Retinal fundus photograph. 2352 by 1568 pixels:
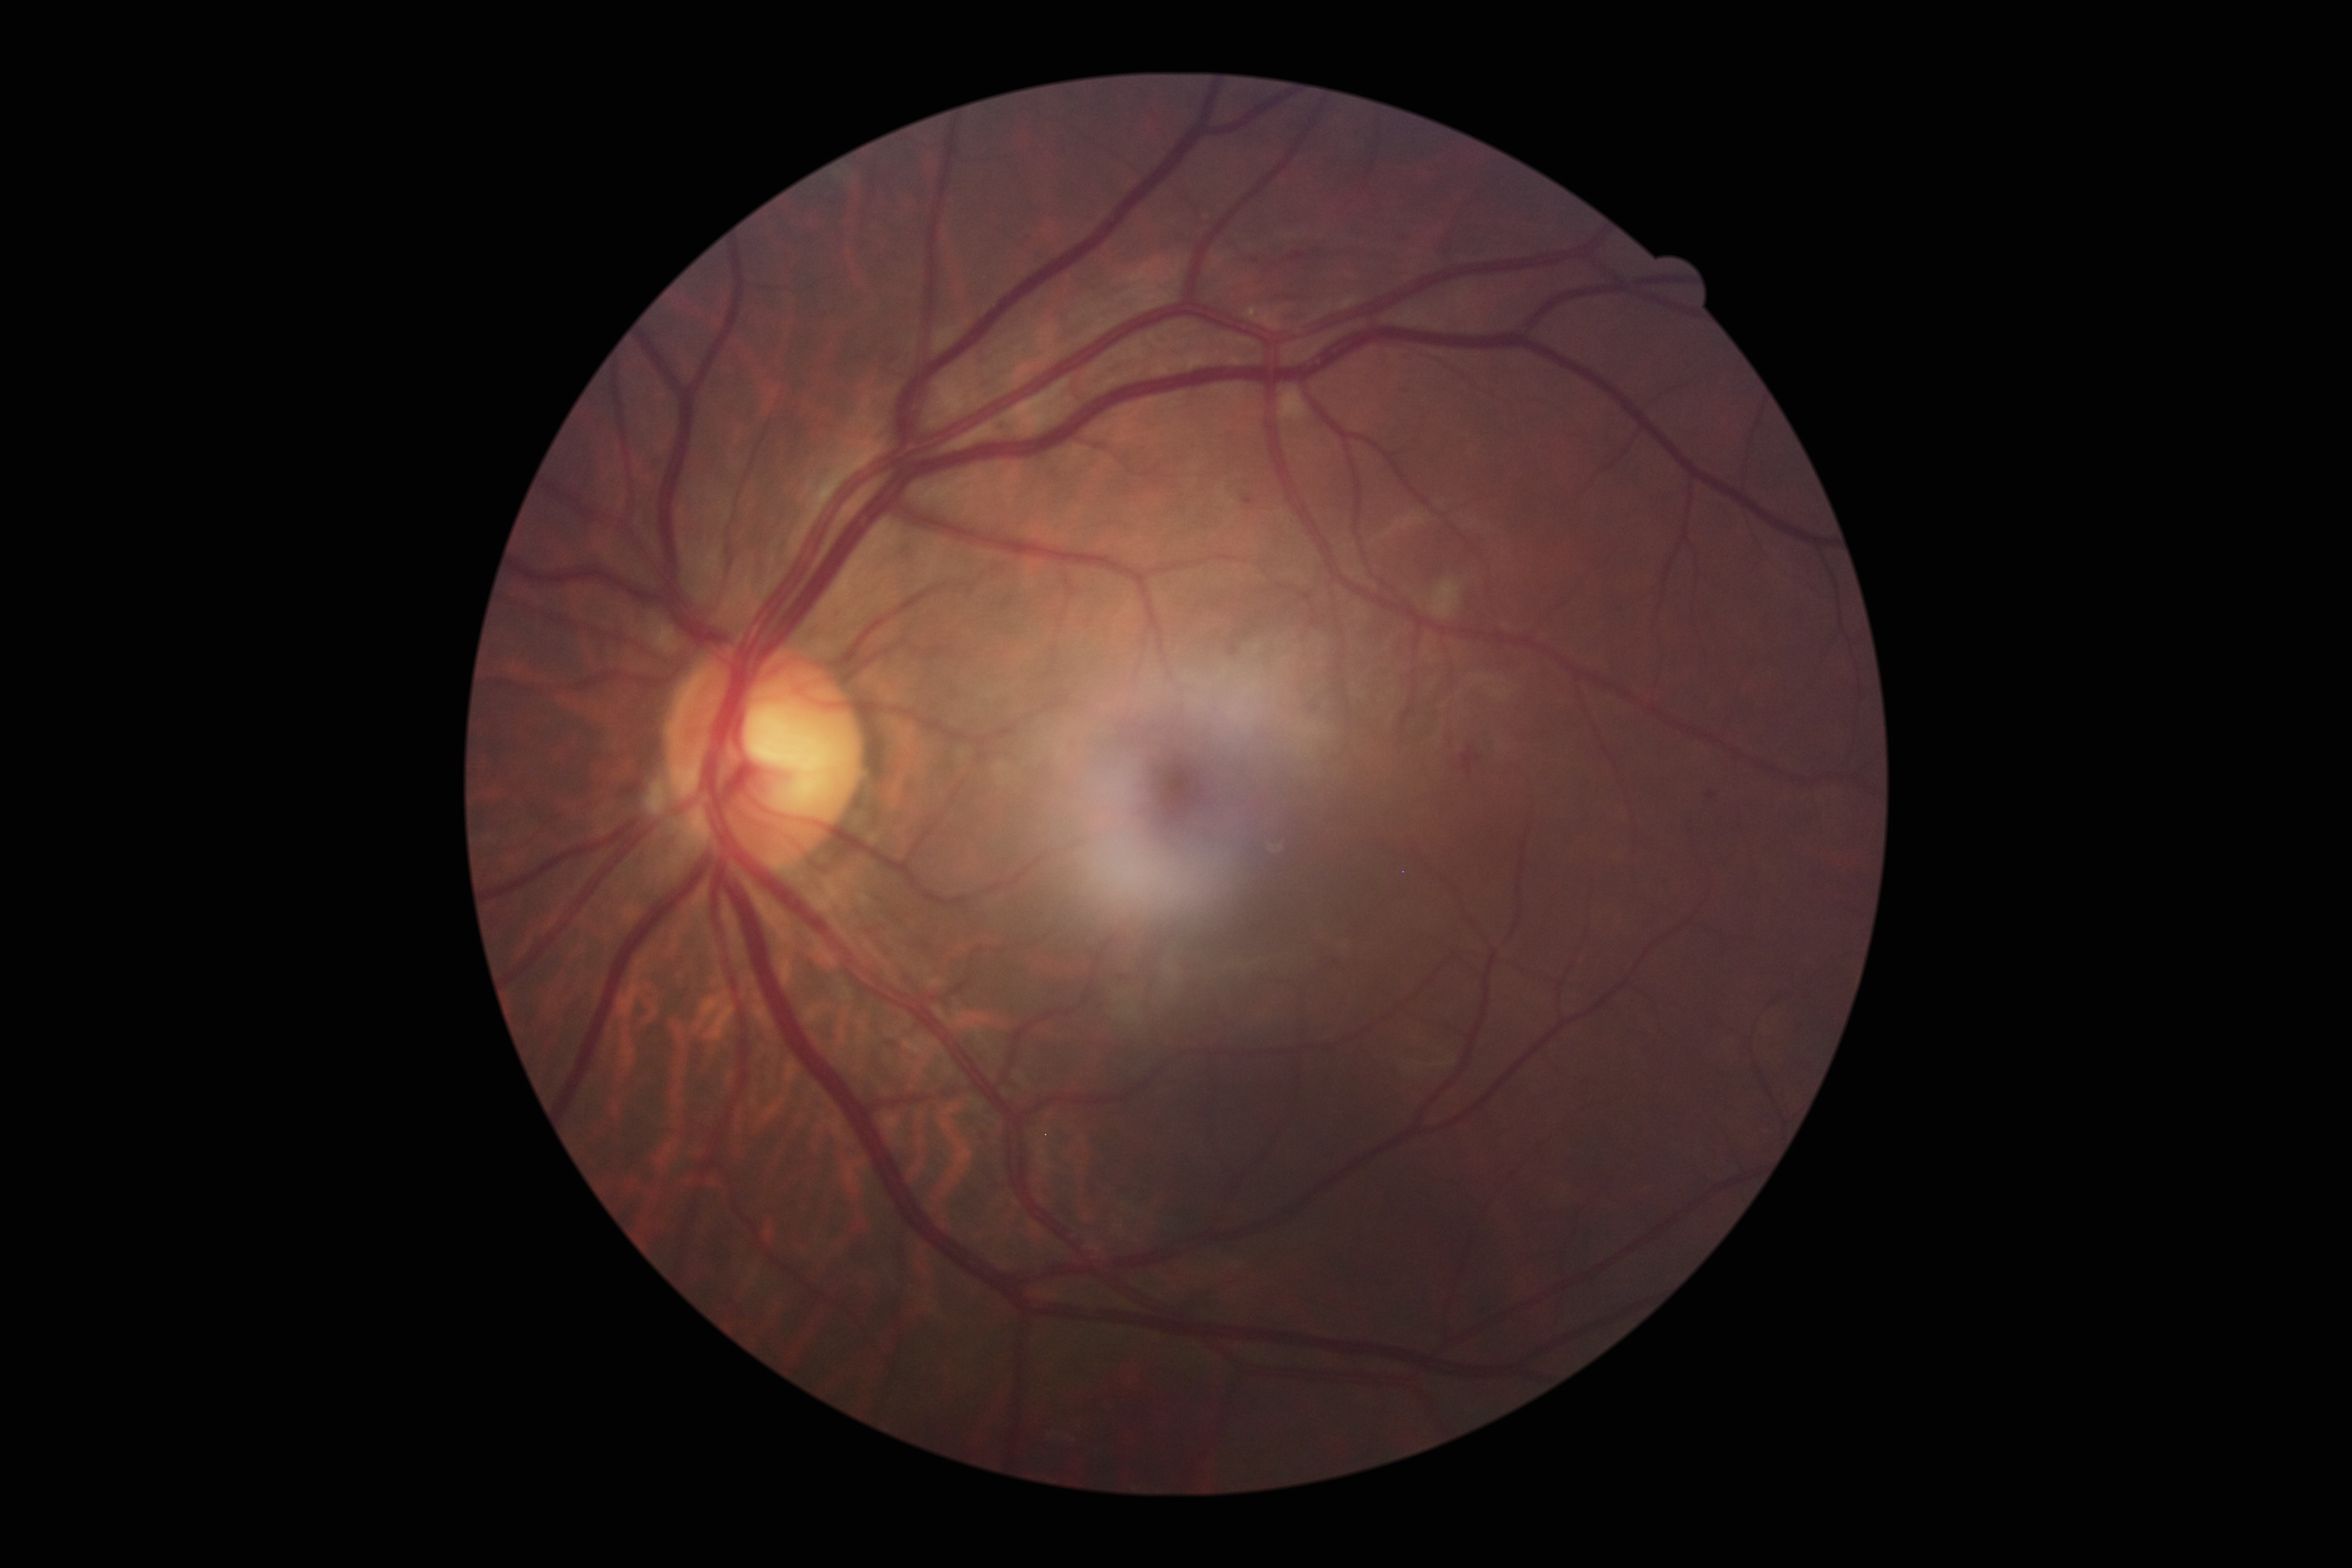

{"dr_grade": "2/4"}